Wide-field contact fundus photograph of an infant; captured with the Phoenix ICON (100° field of view): 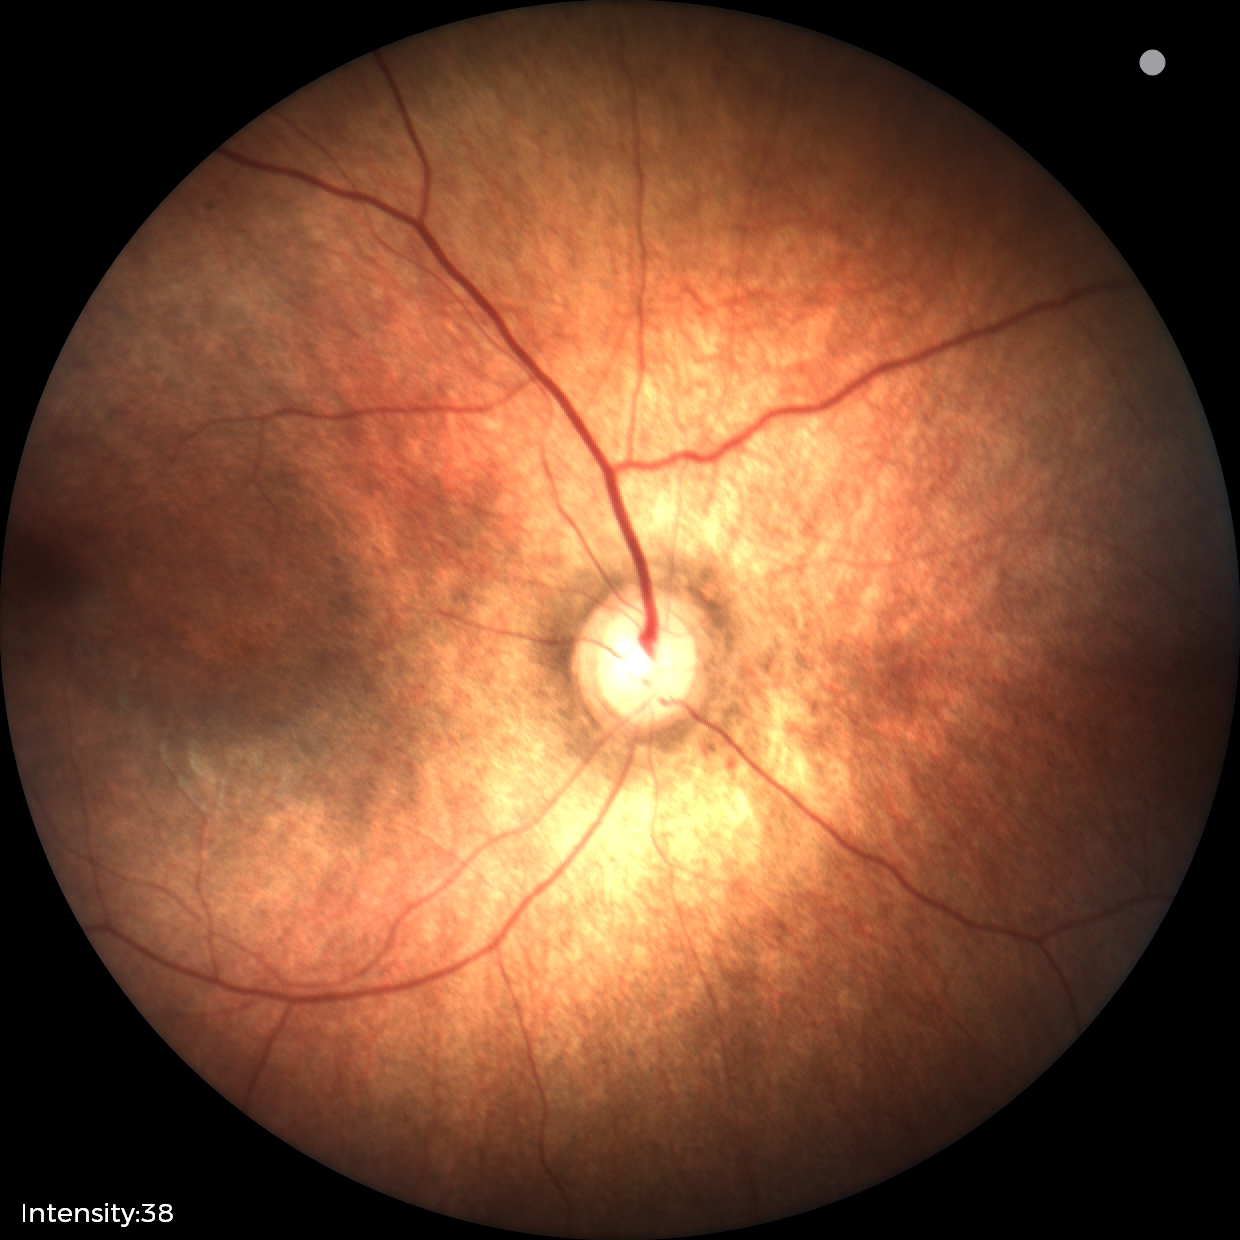 Normal screening examination.